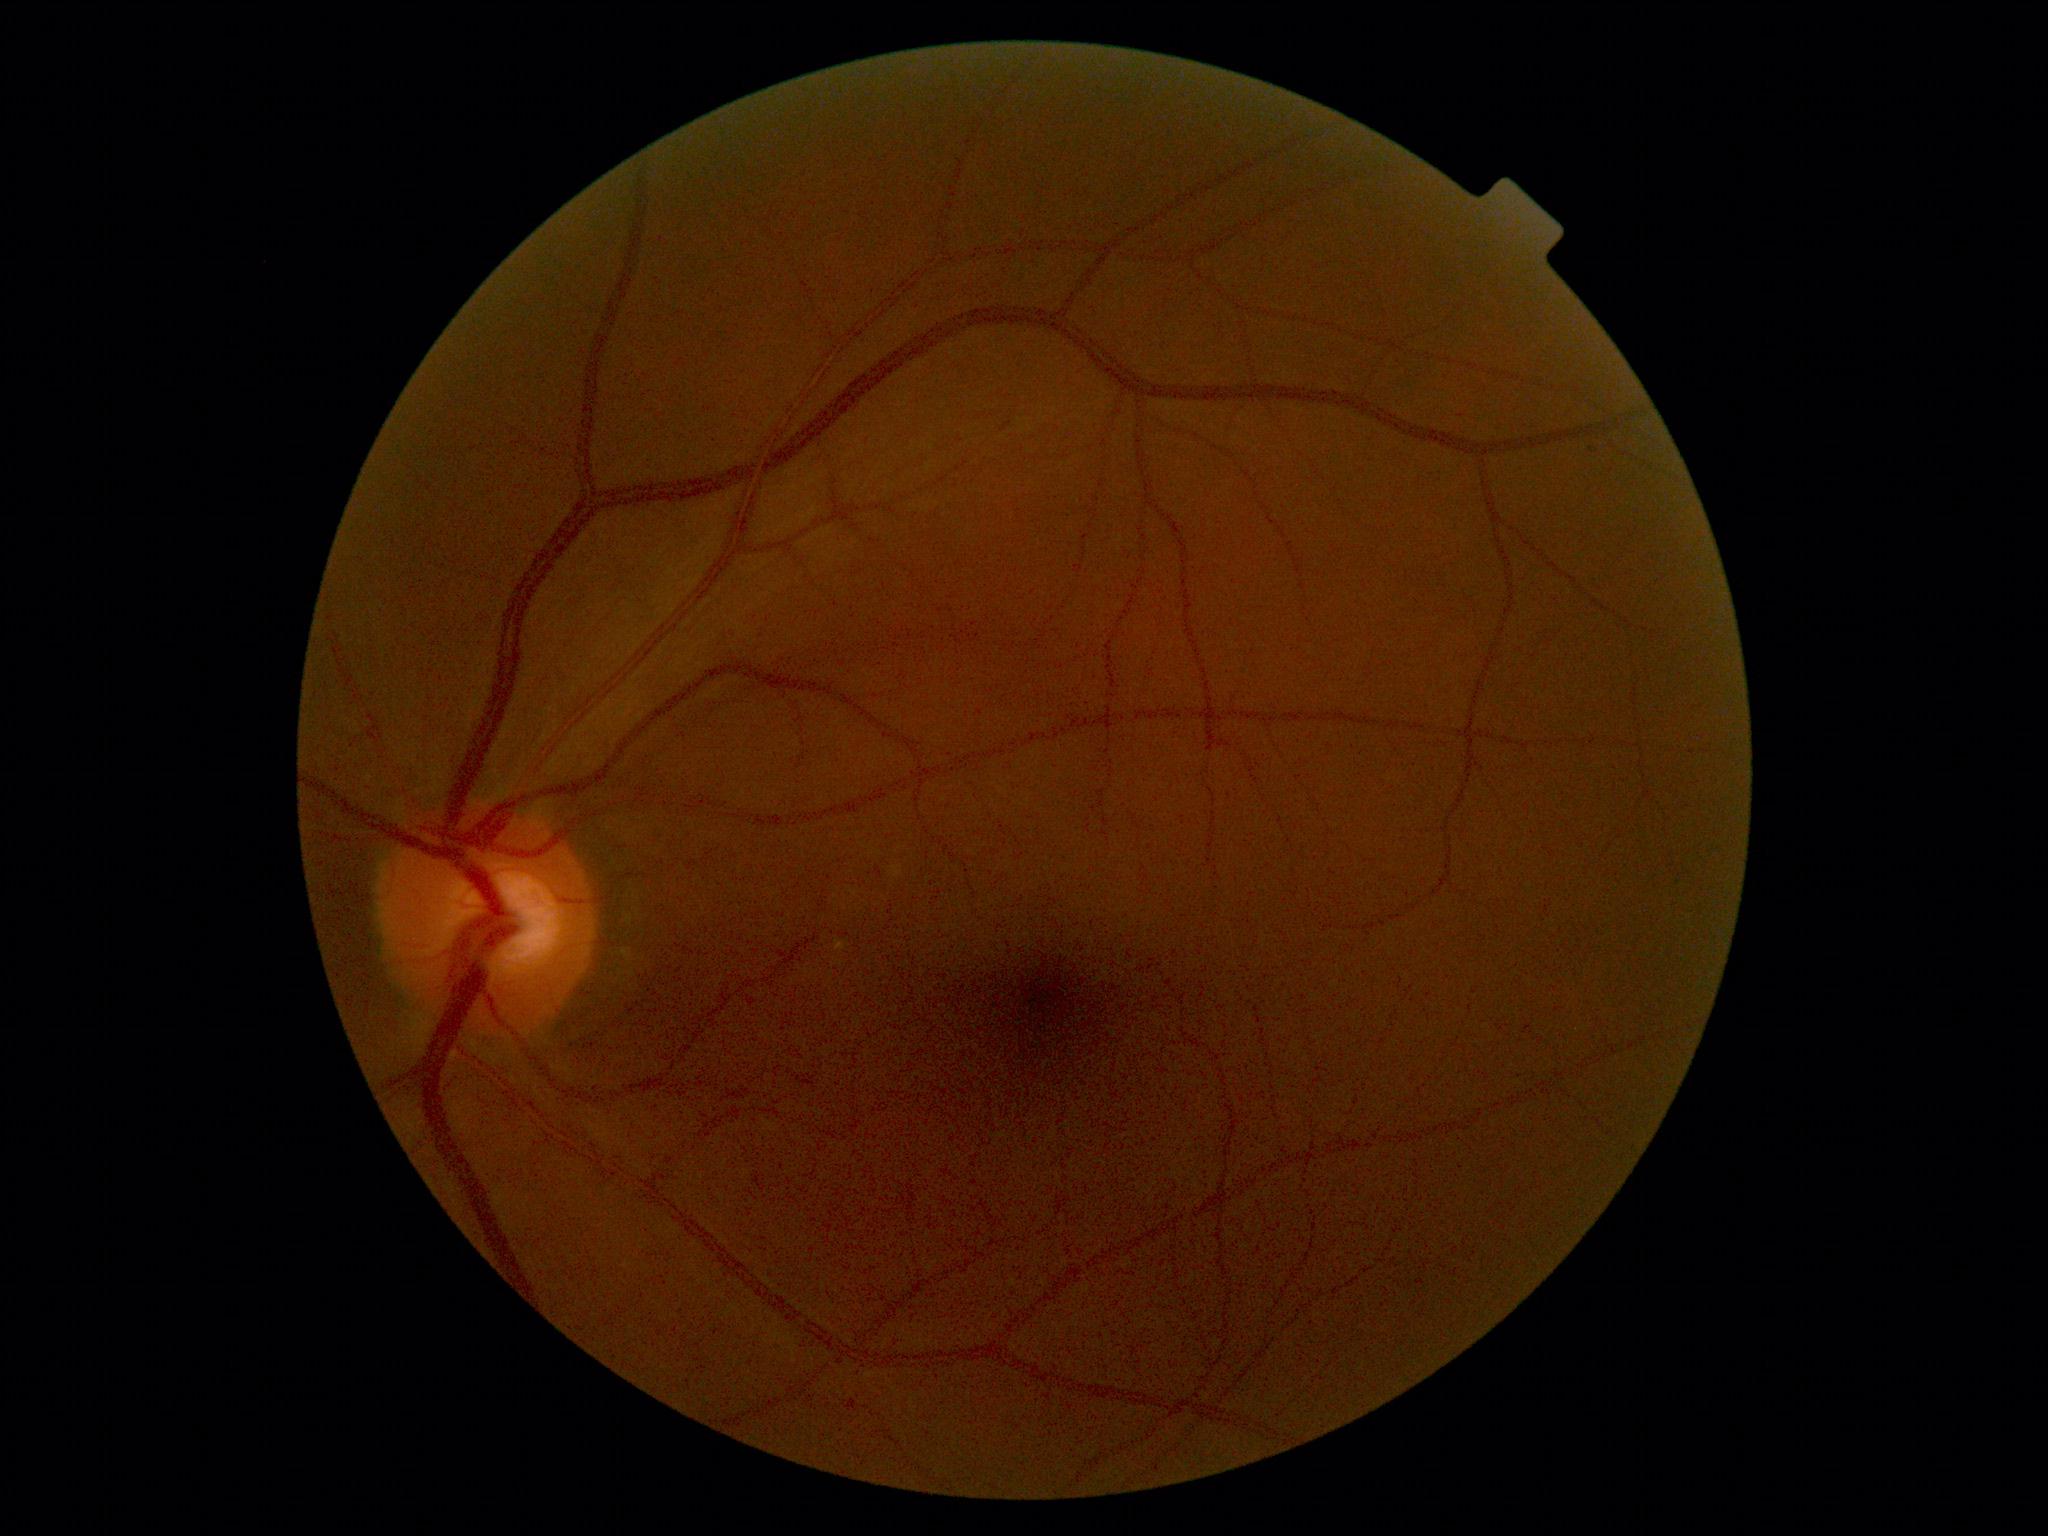

{
  "dr_grade": "0/4"
}